Retinal fundus photograph.
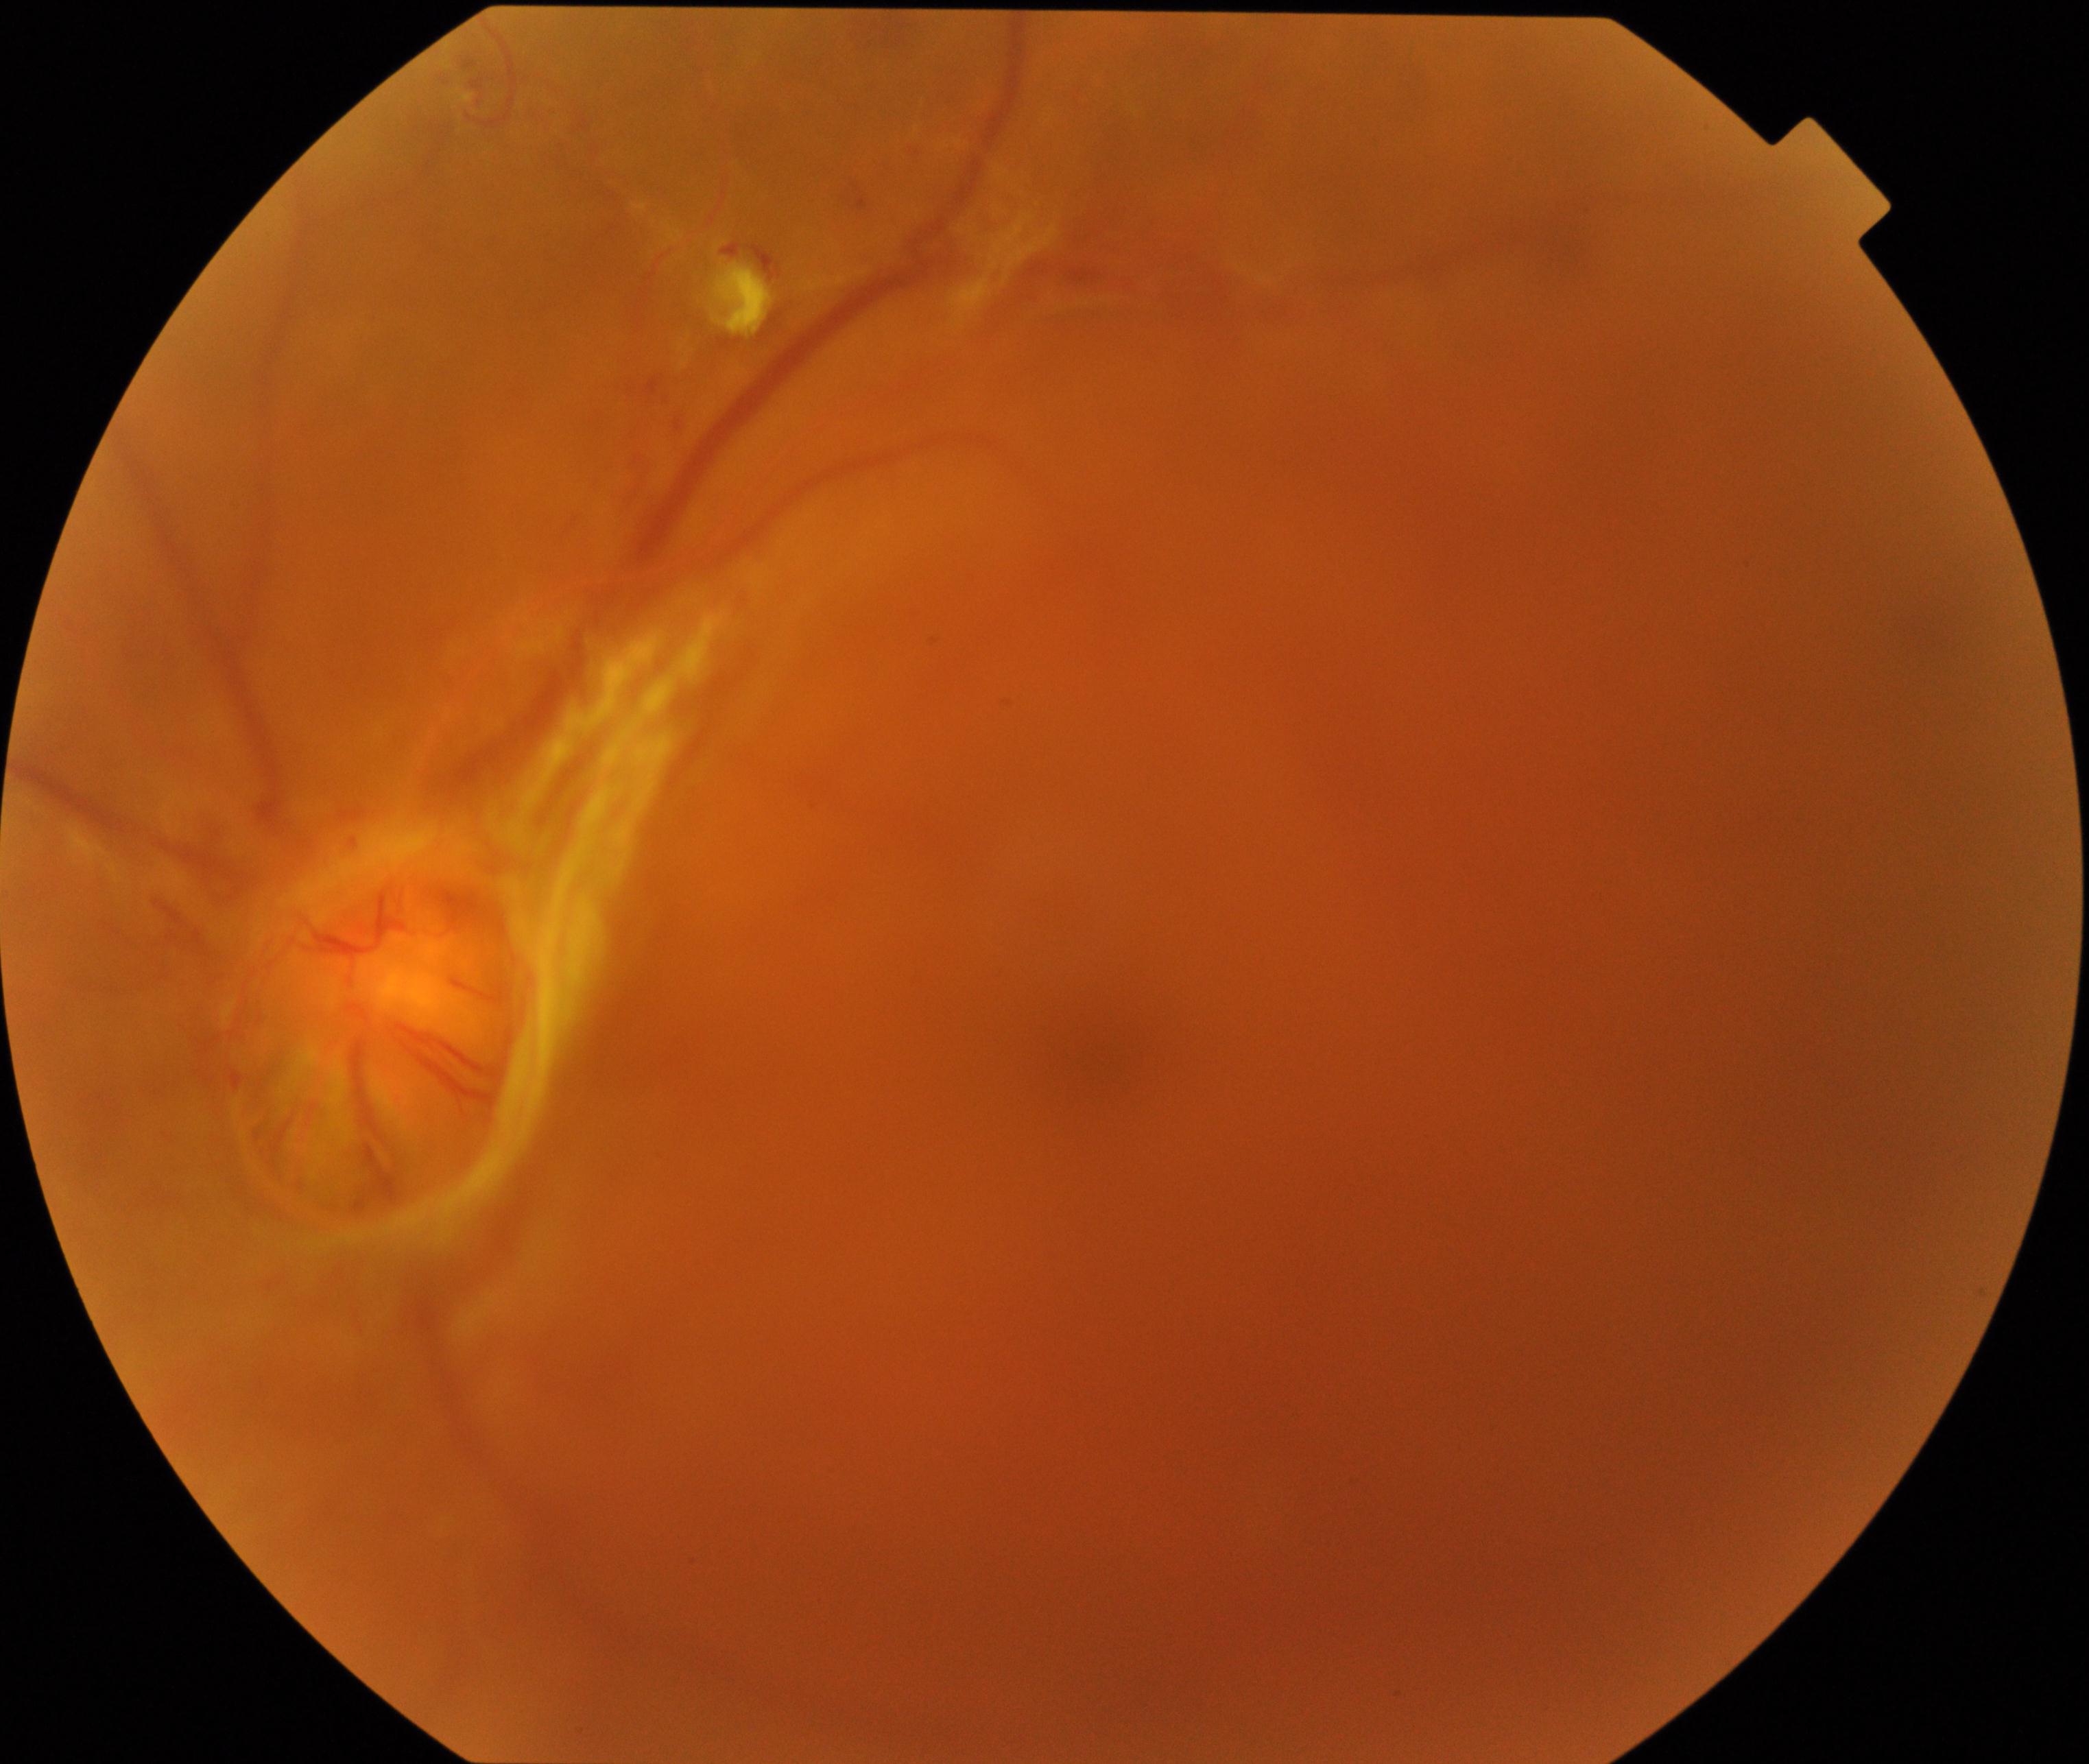

Significantly degraded image quality with obscured retinal detail. Proliferative diabetic retinopathy is suspected.